Image size 2089x1764.
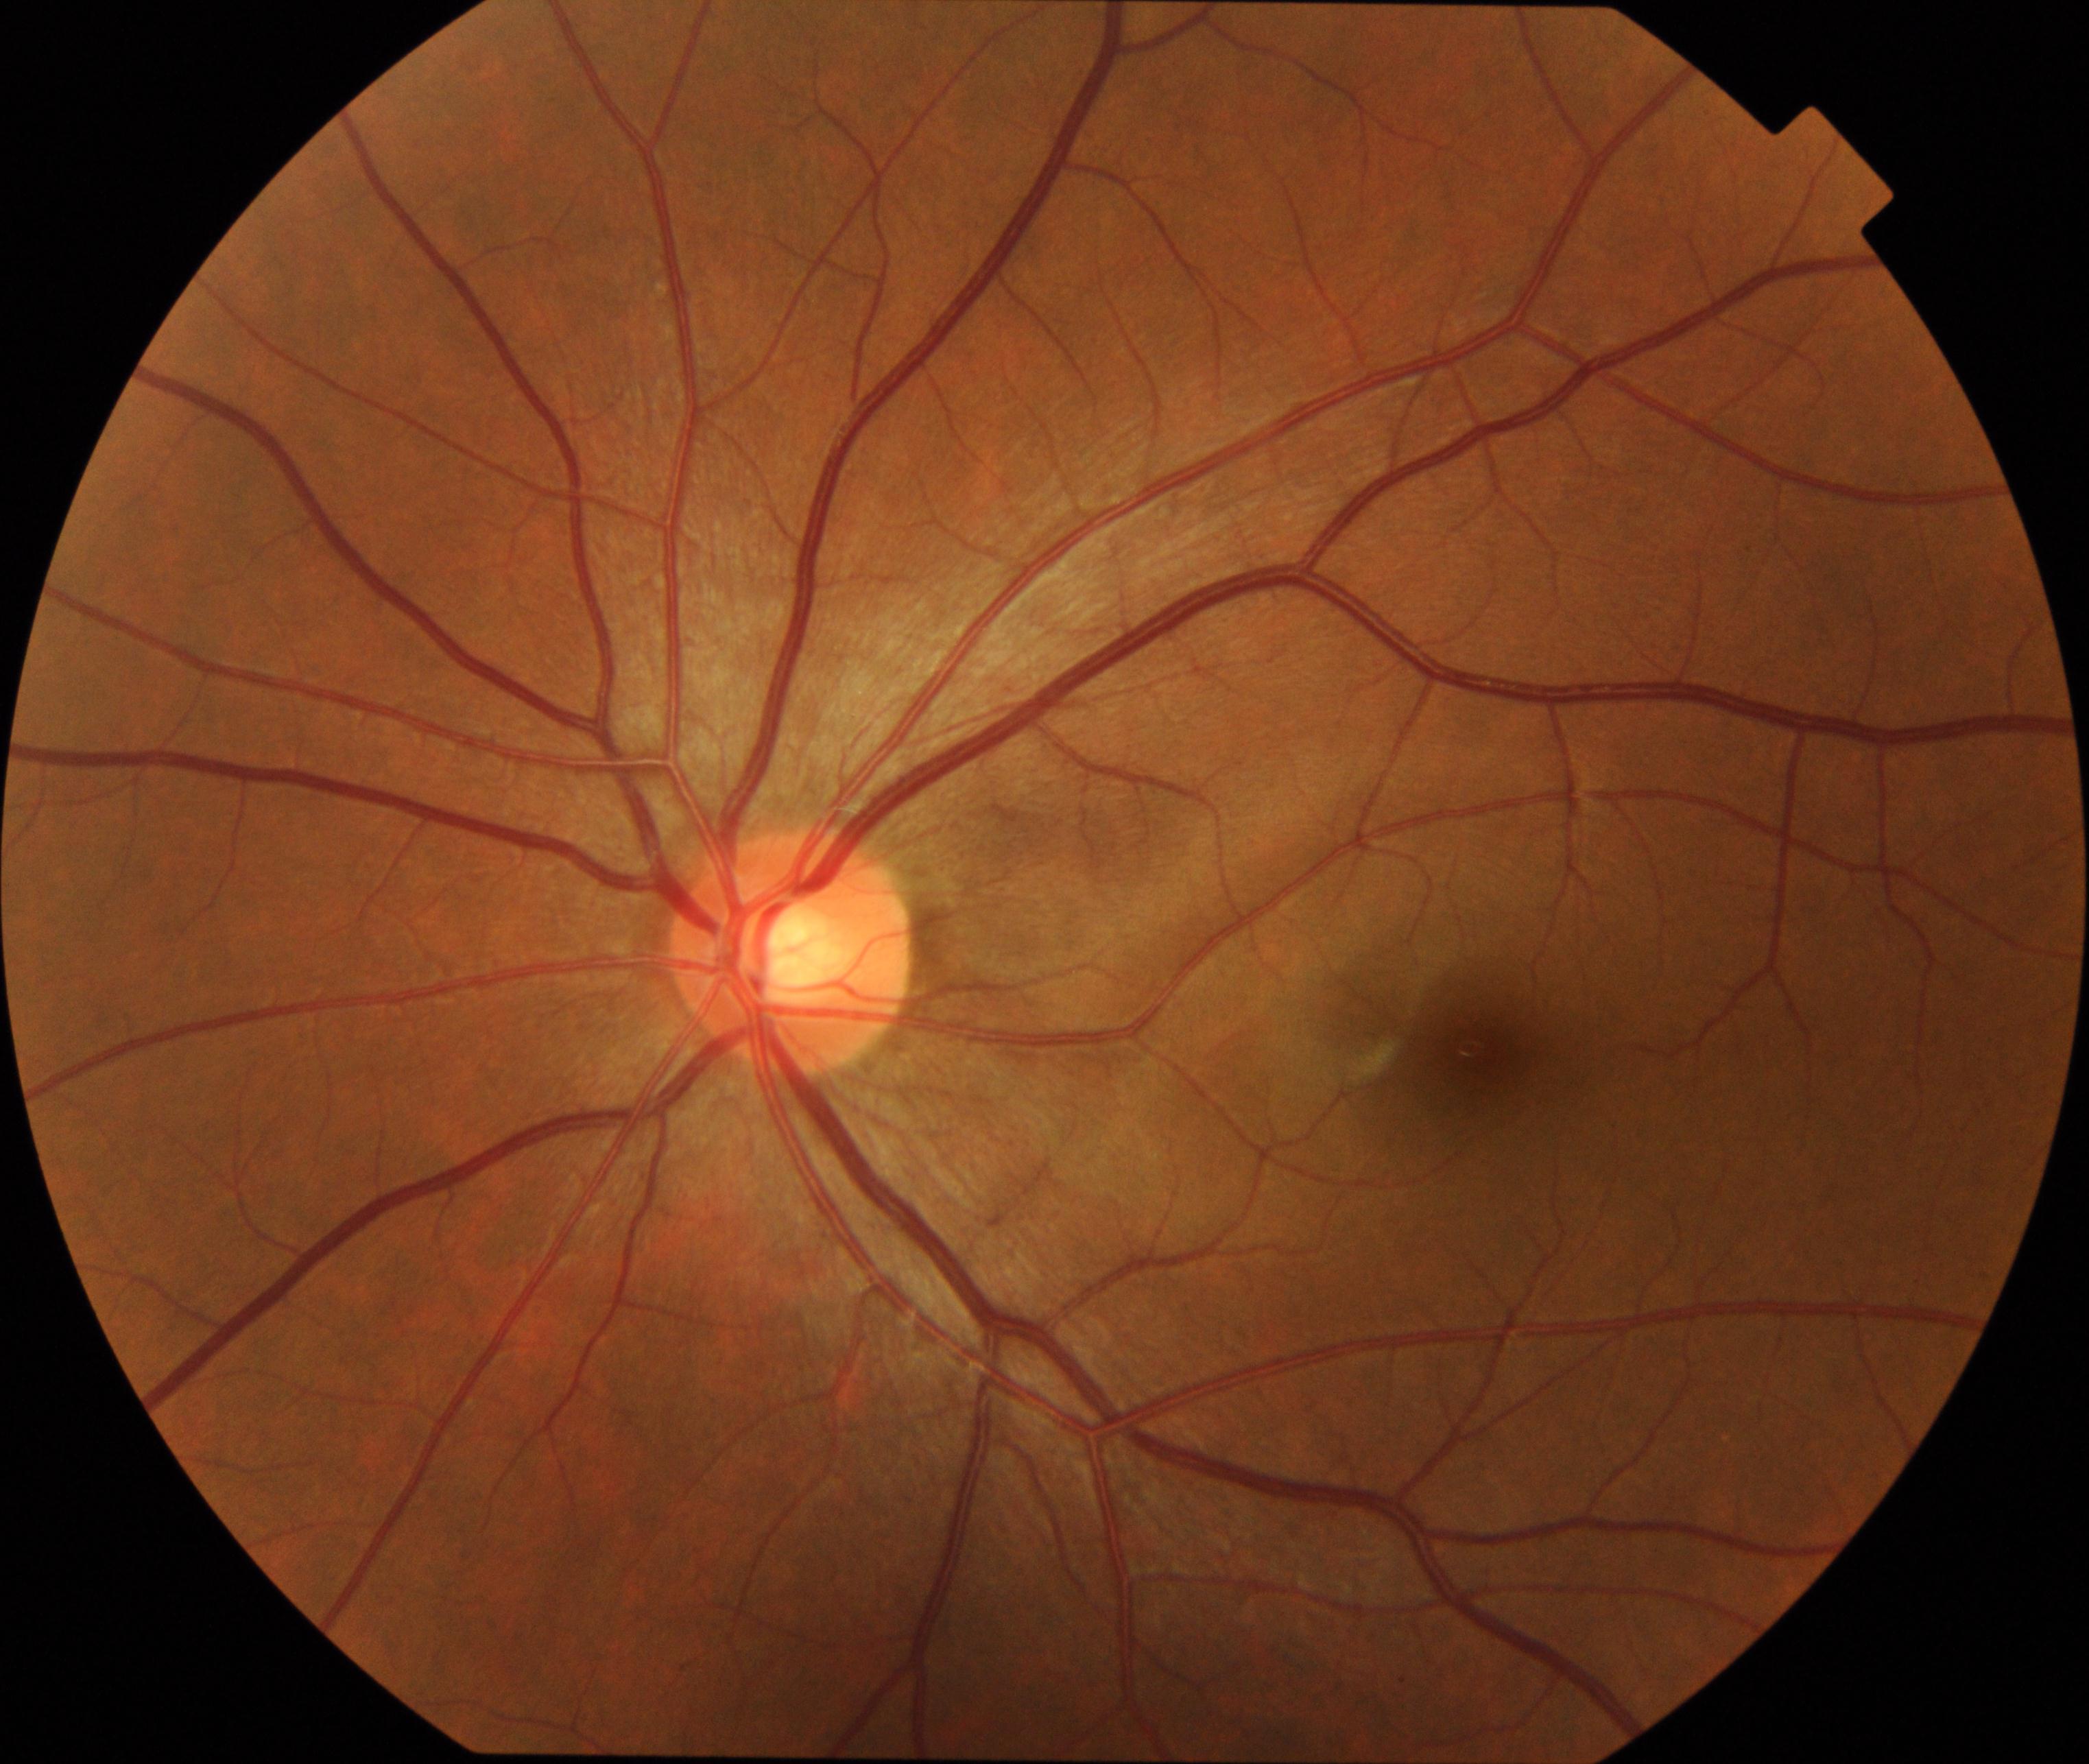

Findings: none. Normal fundus.